Camera: NIDEK AFC-230; retinal fundus photograph; 45-degree field of view; 848x848; modified Davis classification:
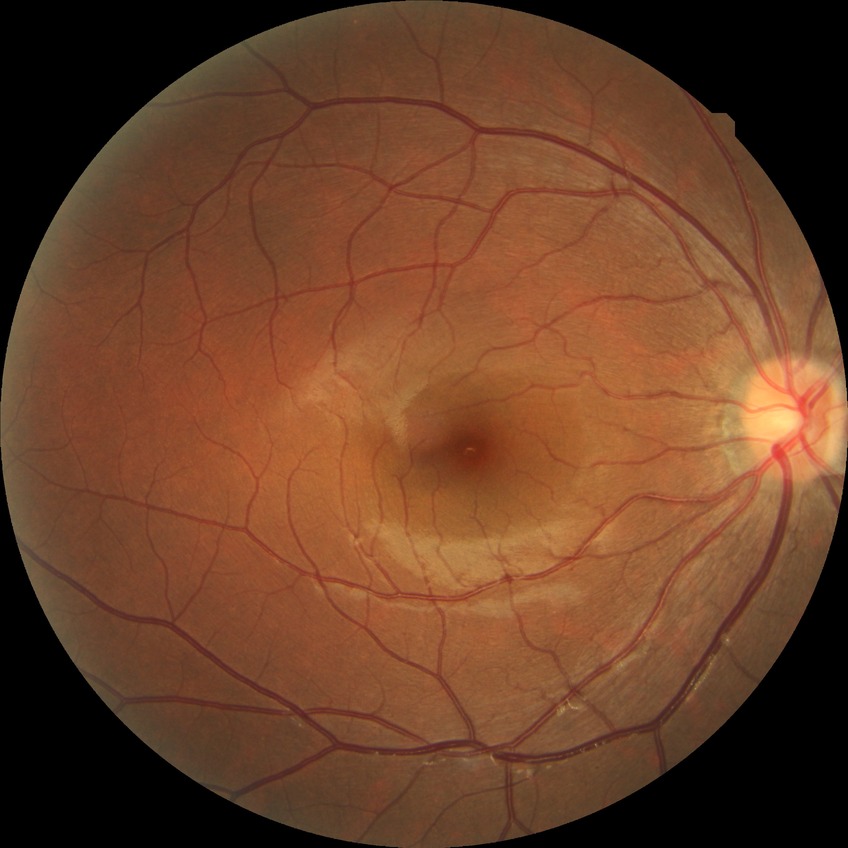

Modified Davis grading: no diabetic retinopathy.